Wide-field fundus image from infant ROP screening. 640x480
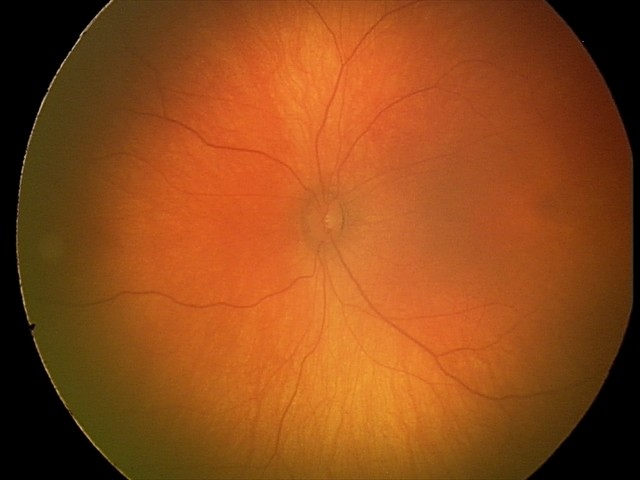

Examination with physiological retinal findings.